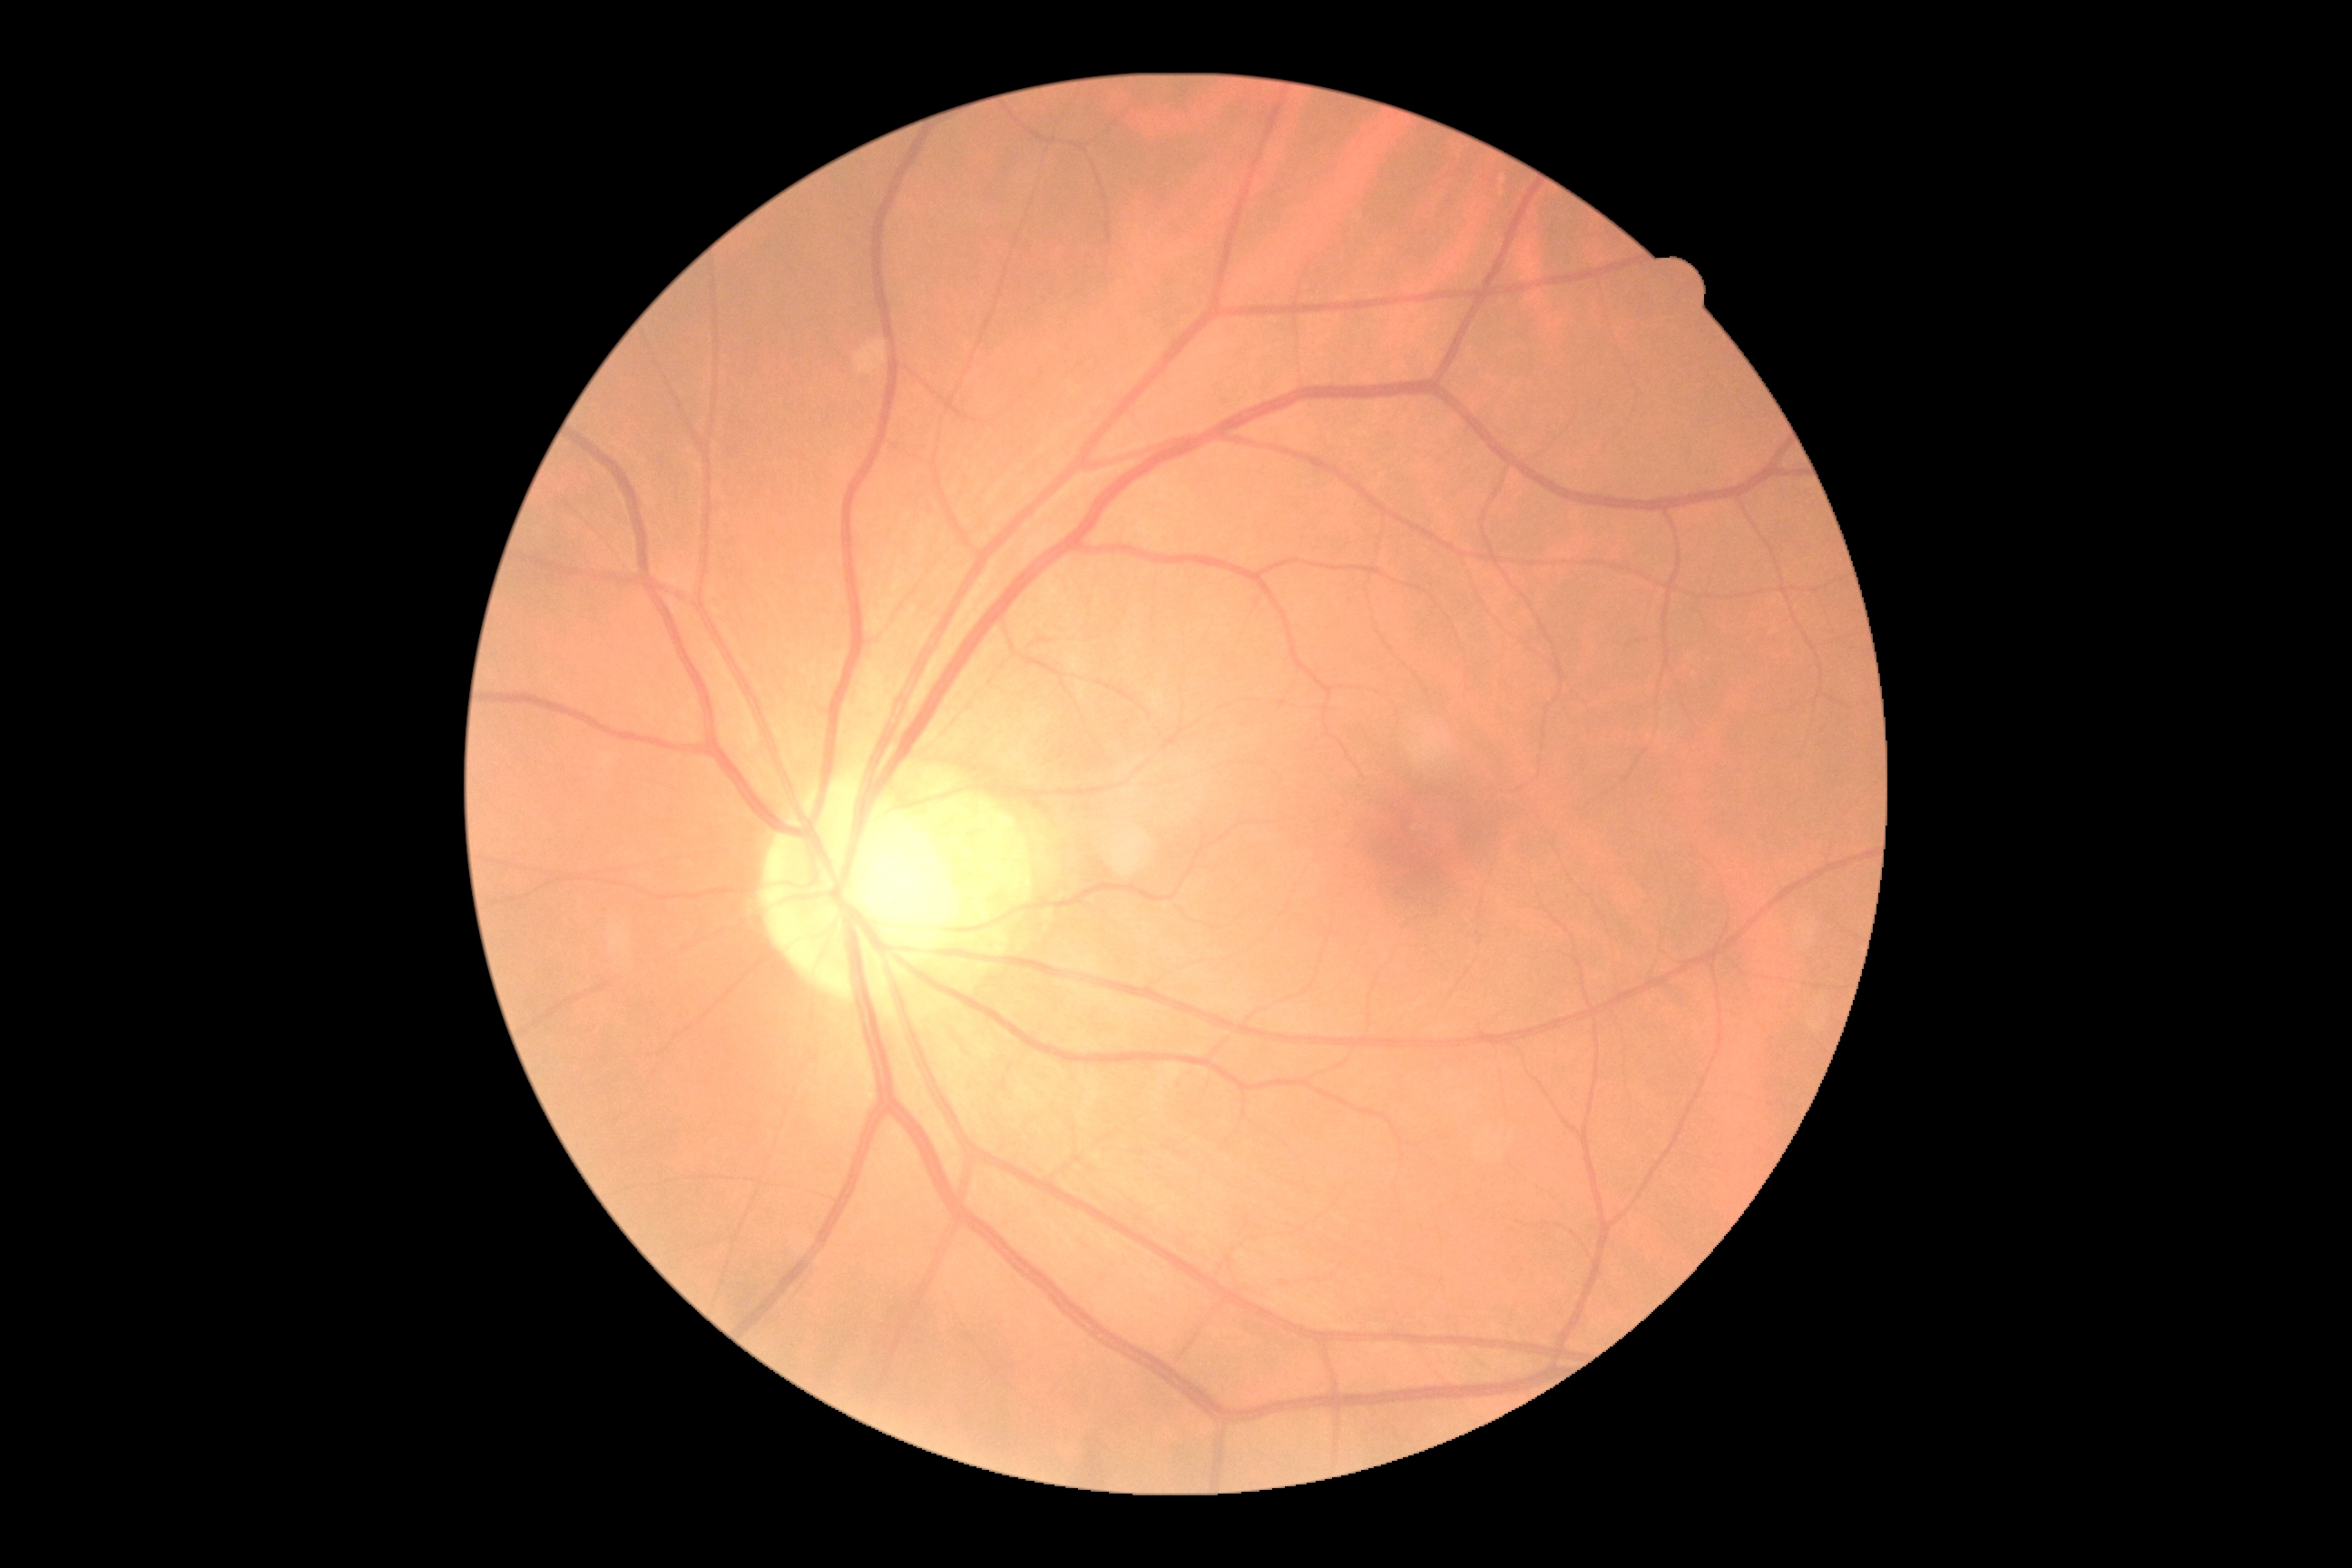 diabetic retinopathy grade: 0 (no apparent retinopathy).